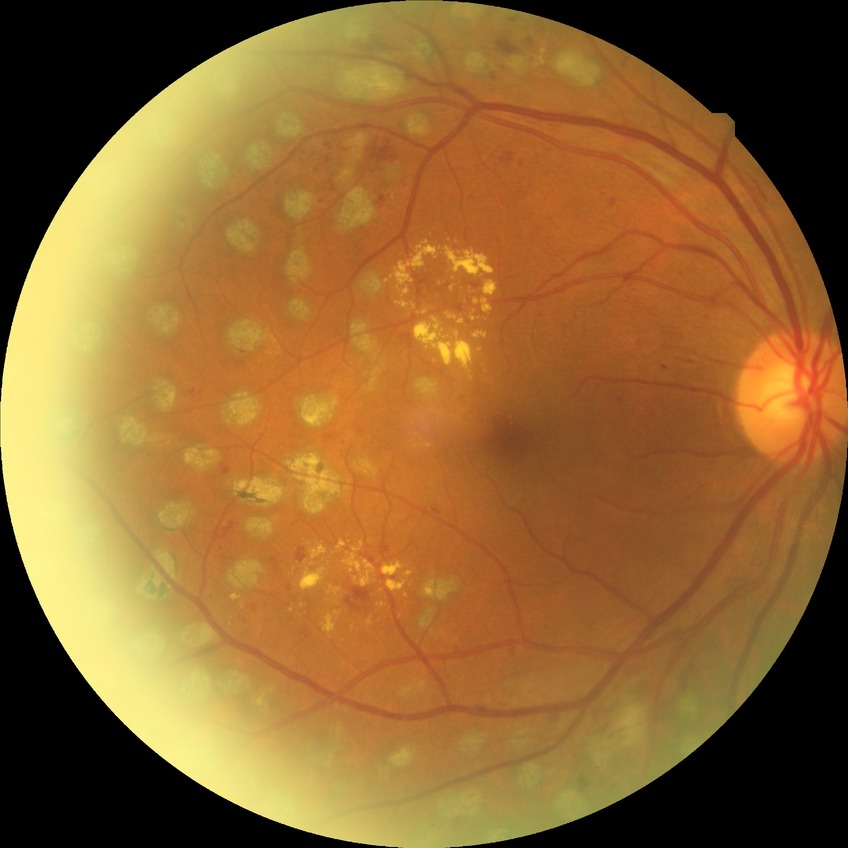

Diabetic retinopathy (DR): PDR (proliferative diabetic retinopathy).